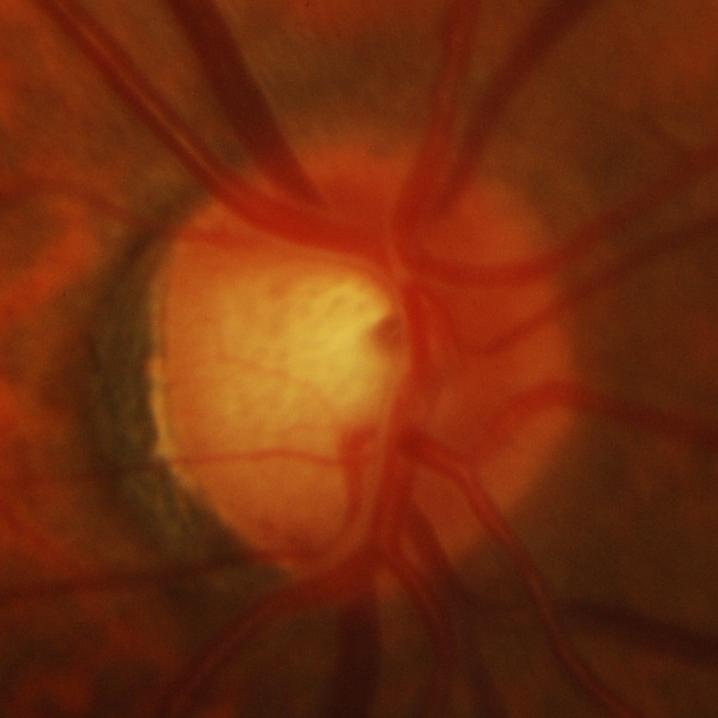
Glaucoma status = glaucomatous damage to the optic nerve.